Davis DR grading; NIDEK AFC-230 fundus camera
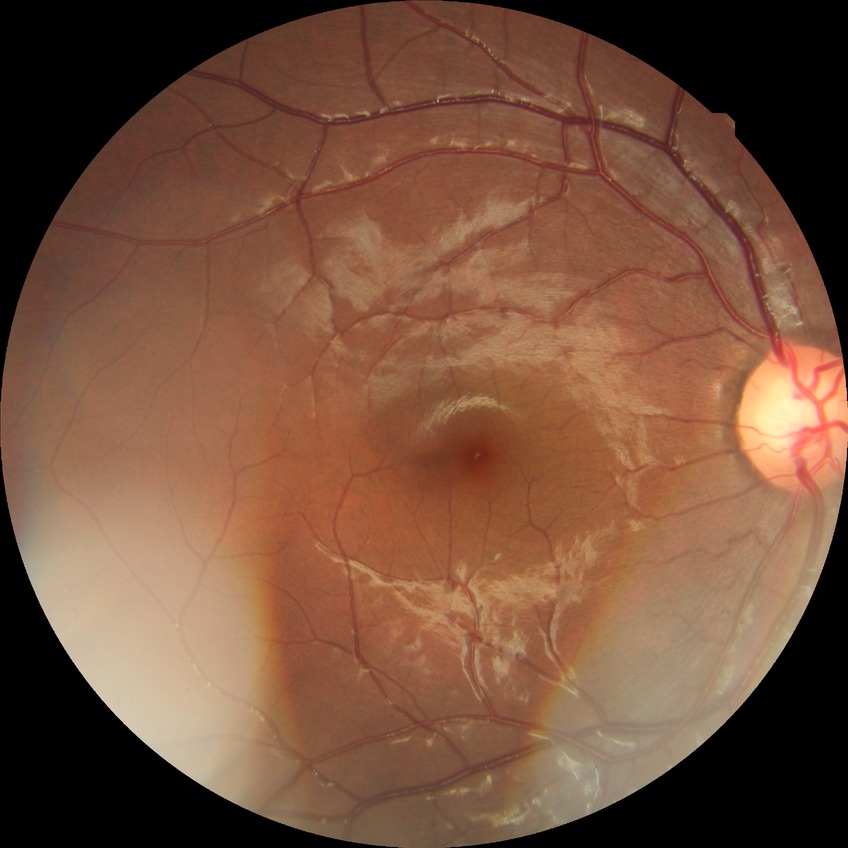

Davis stage is NDR.